45 degree fundus photograph. 848 x 848 pixels. Color fundus image.
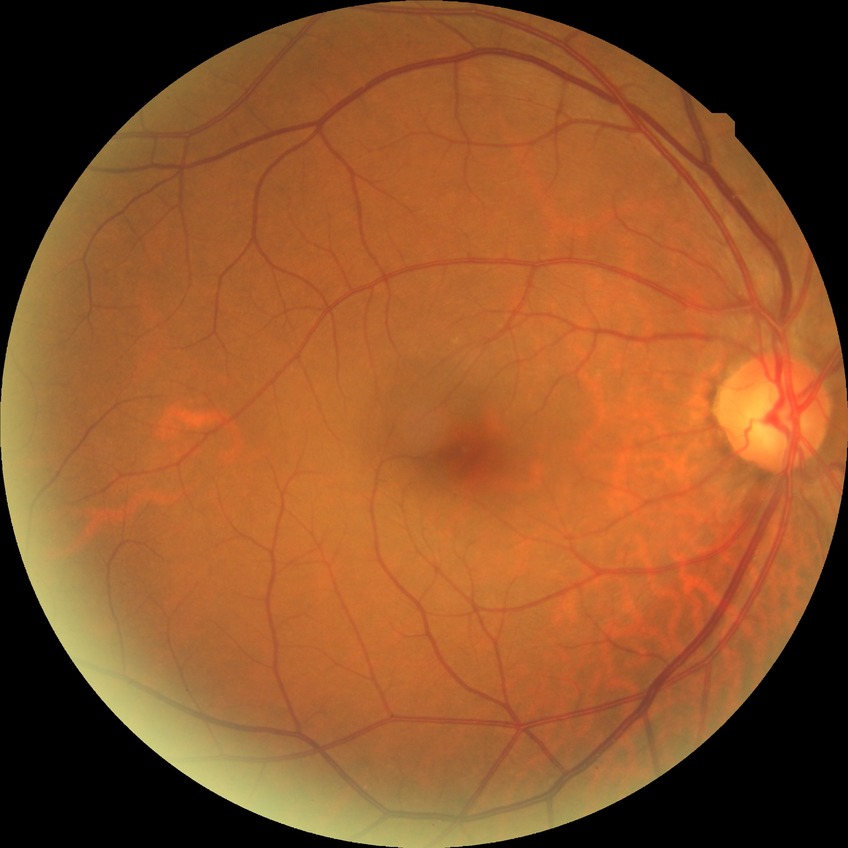

DR impression: no signs of DR; Davis stage: NDR.